Davis DR grading: 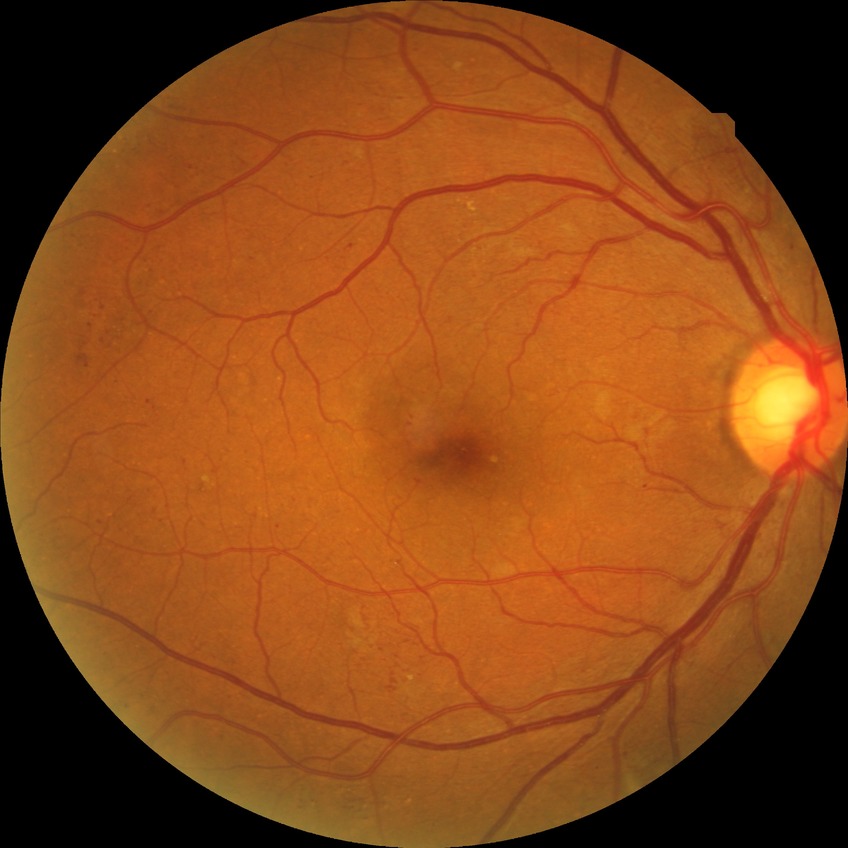

{"davis_grade": "PPDR (pre-proliferative diabetic retinopathy)"}